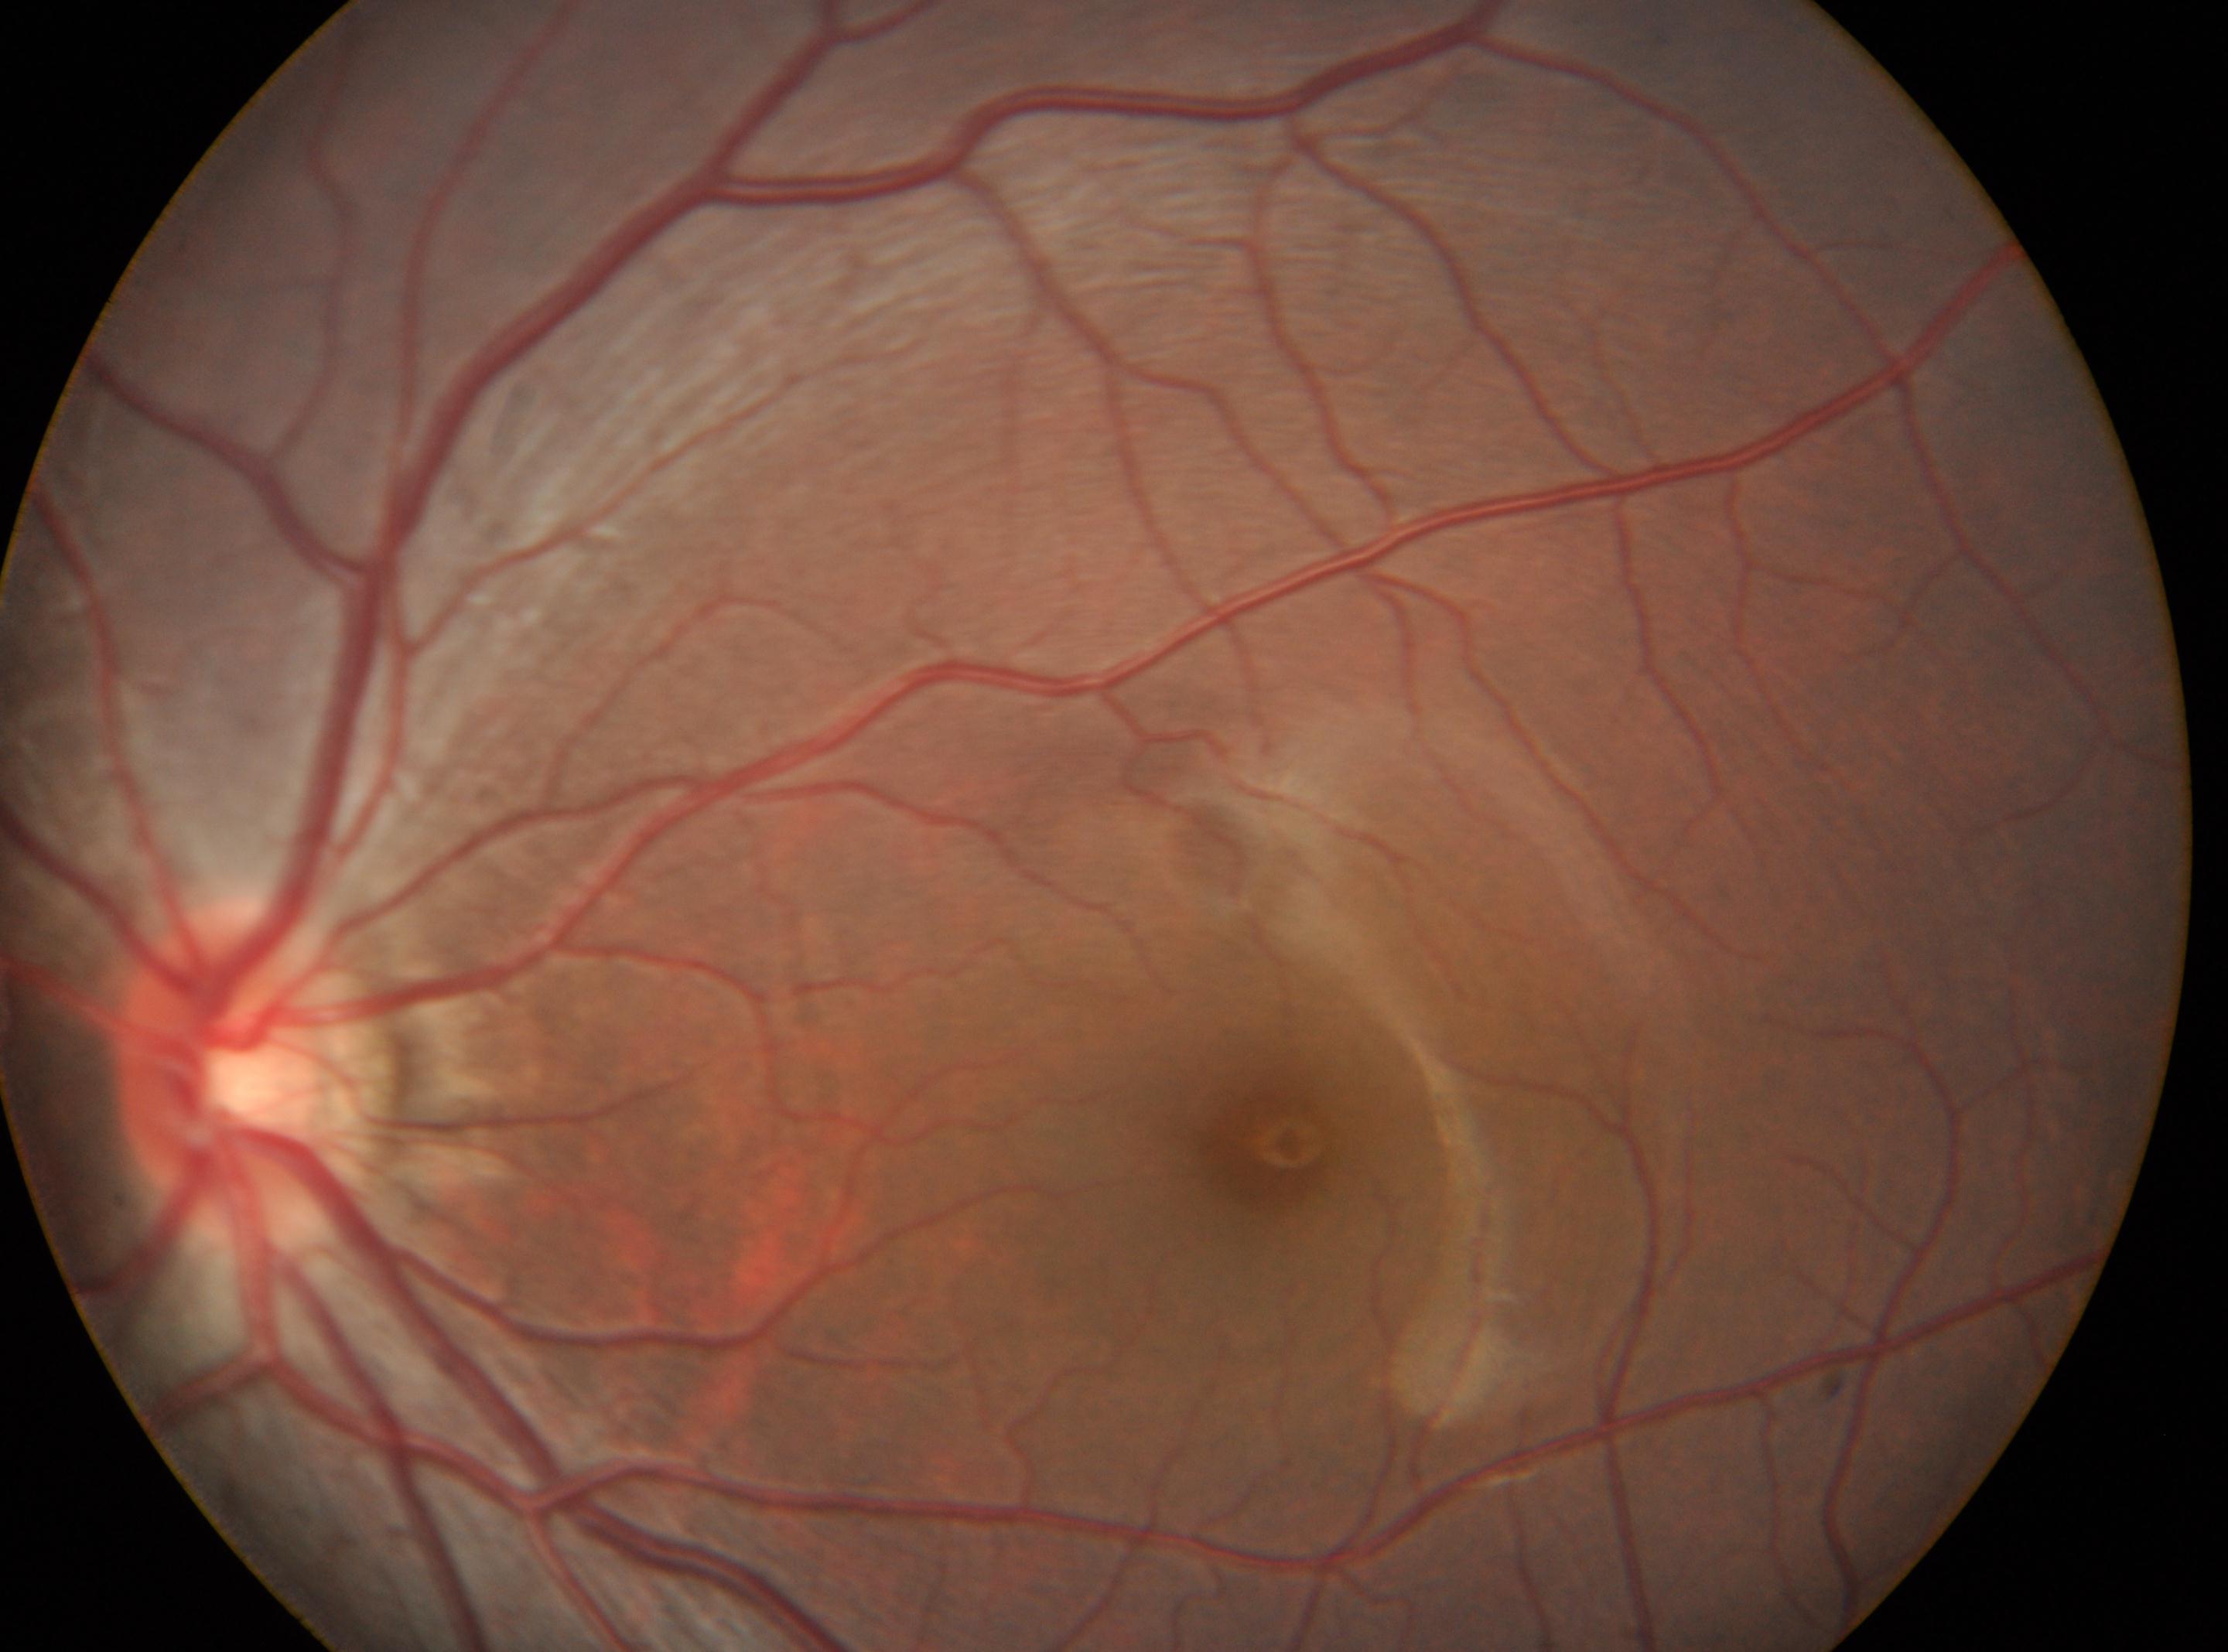 Annotations:
- optic disk — (x=258, y=1070)
- fovea centralis — (x=1272, y=1145)
- retinopathy — grade 0
- laterality — the left eye